Without pupil dilation
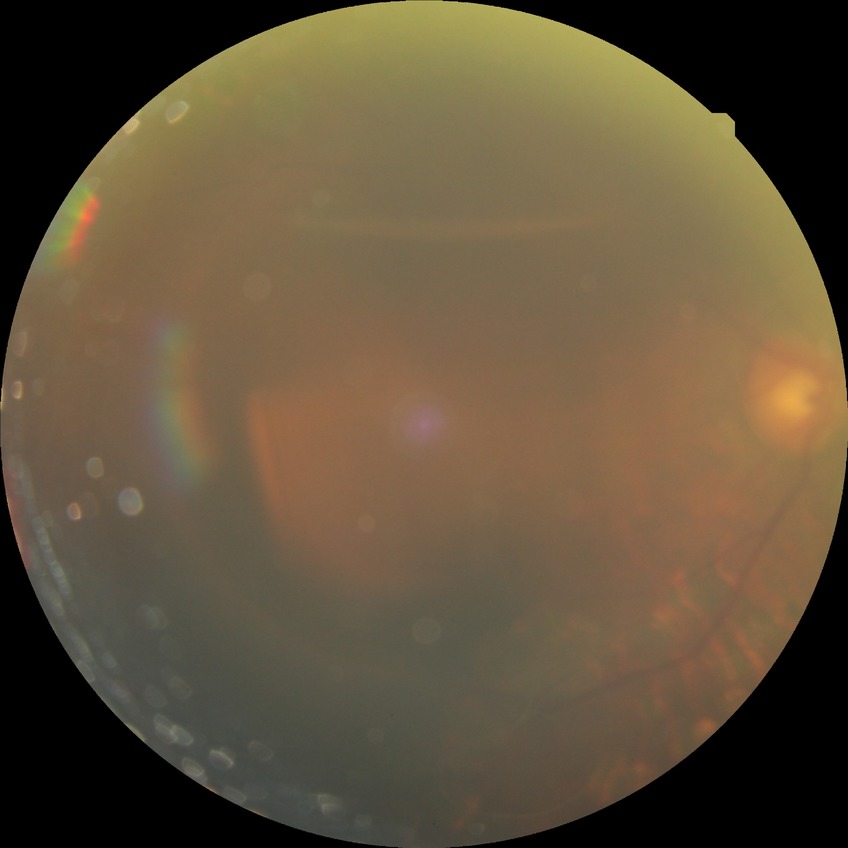
davis_grade: PDR (proliferative diabetic retinopathy)